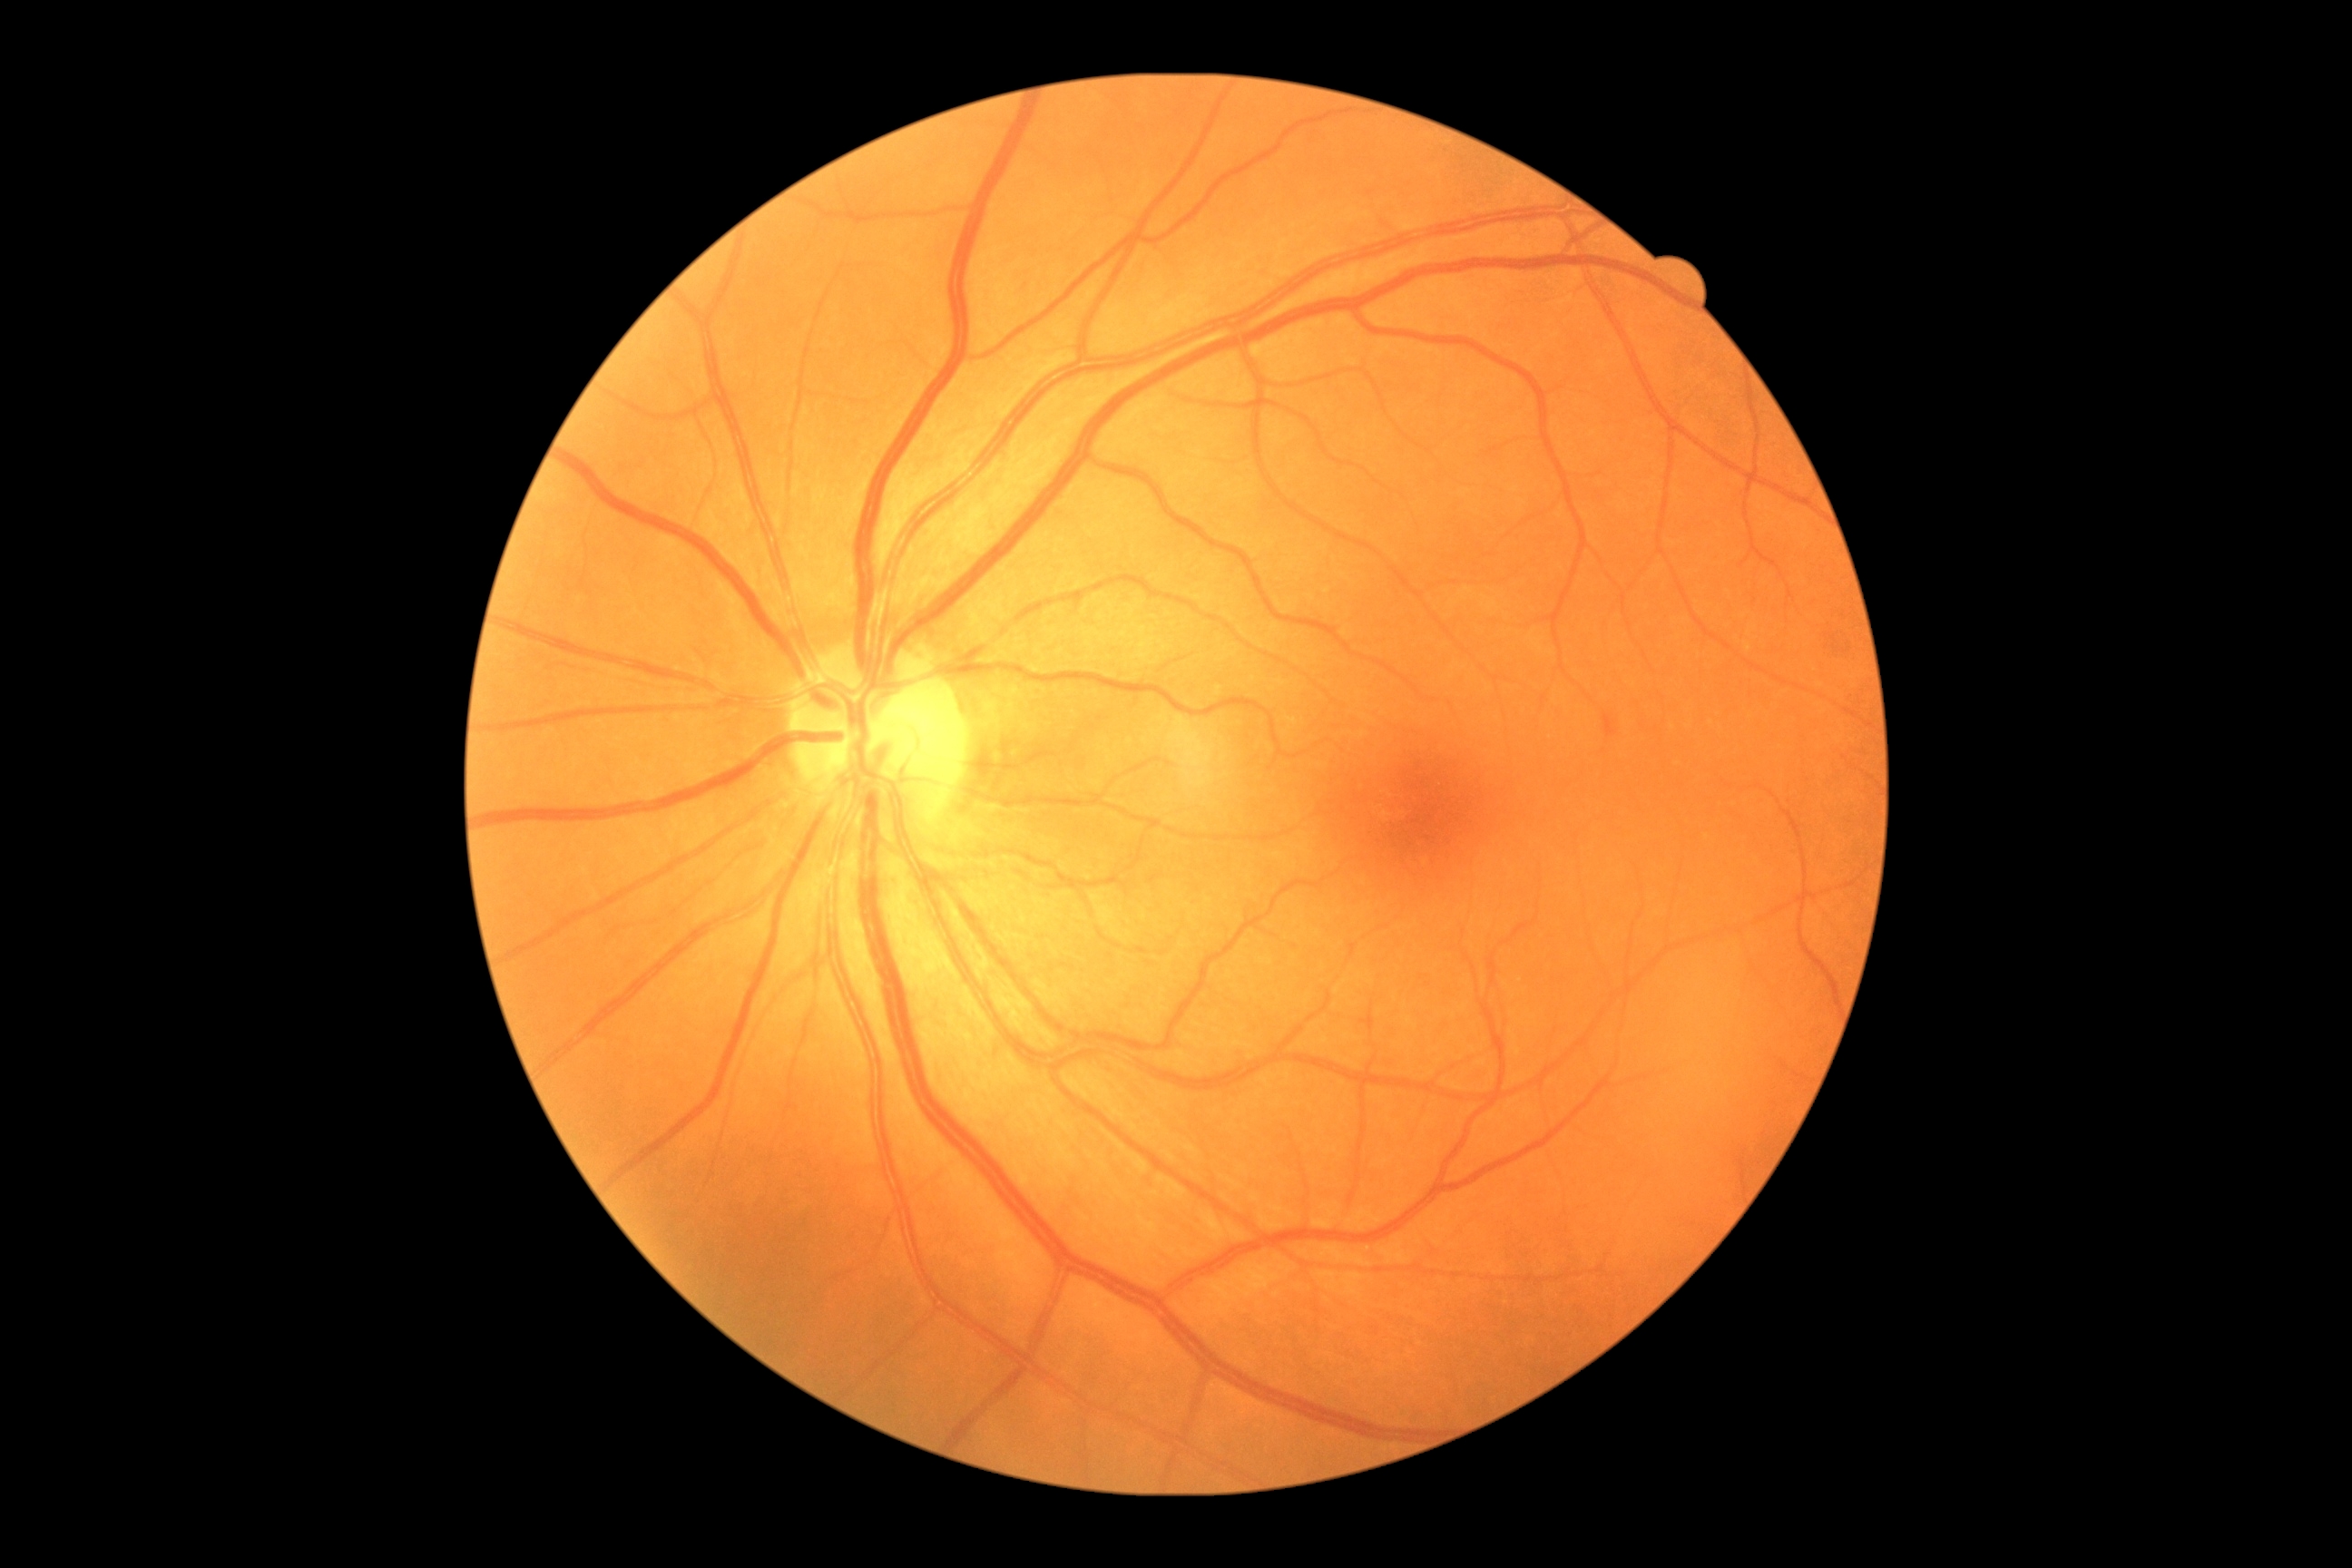 DR severity: no apparent retinopathy (grade 0)